FOV: 45 degrees. Fundus photo:
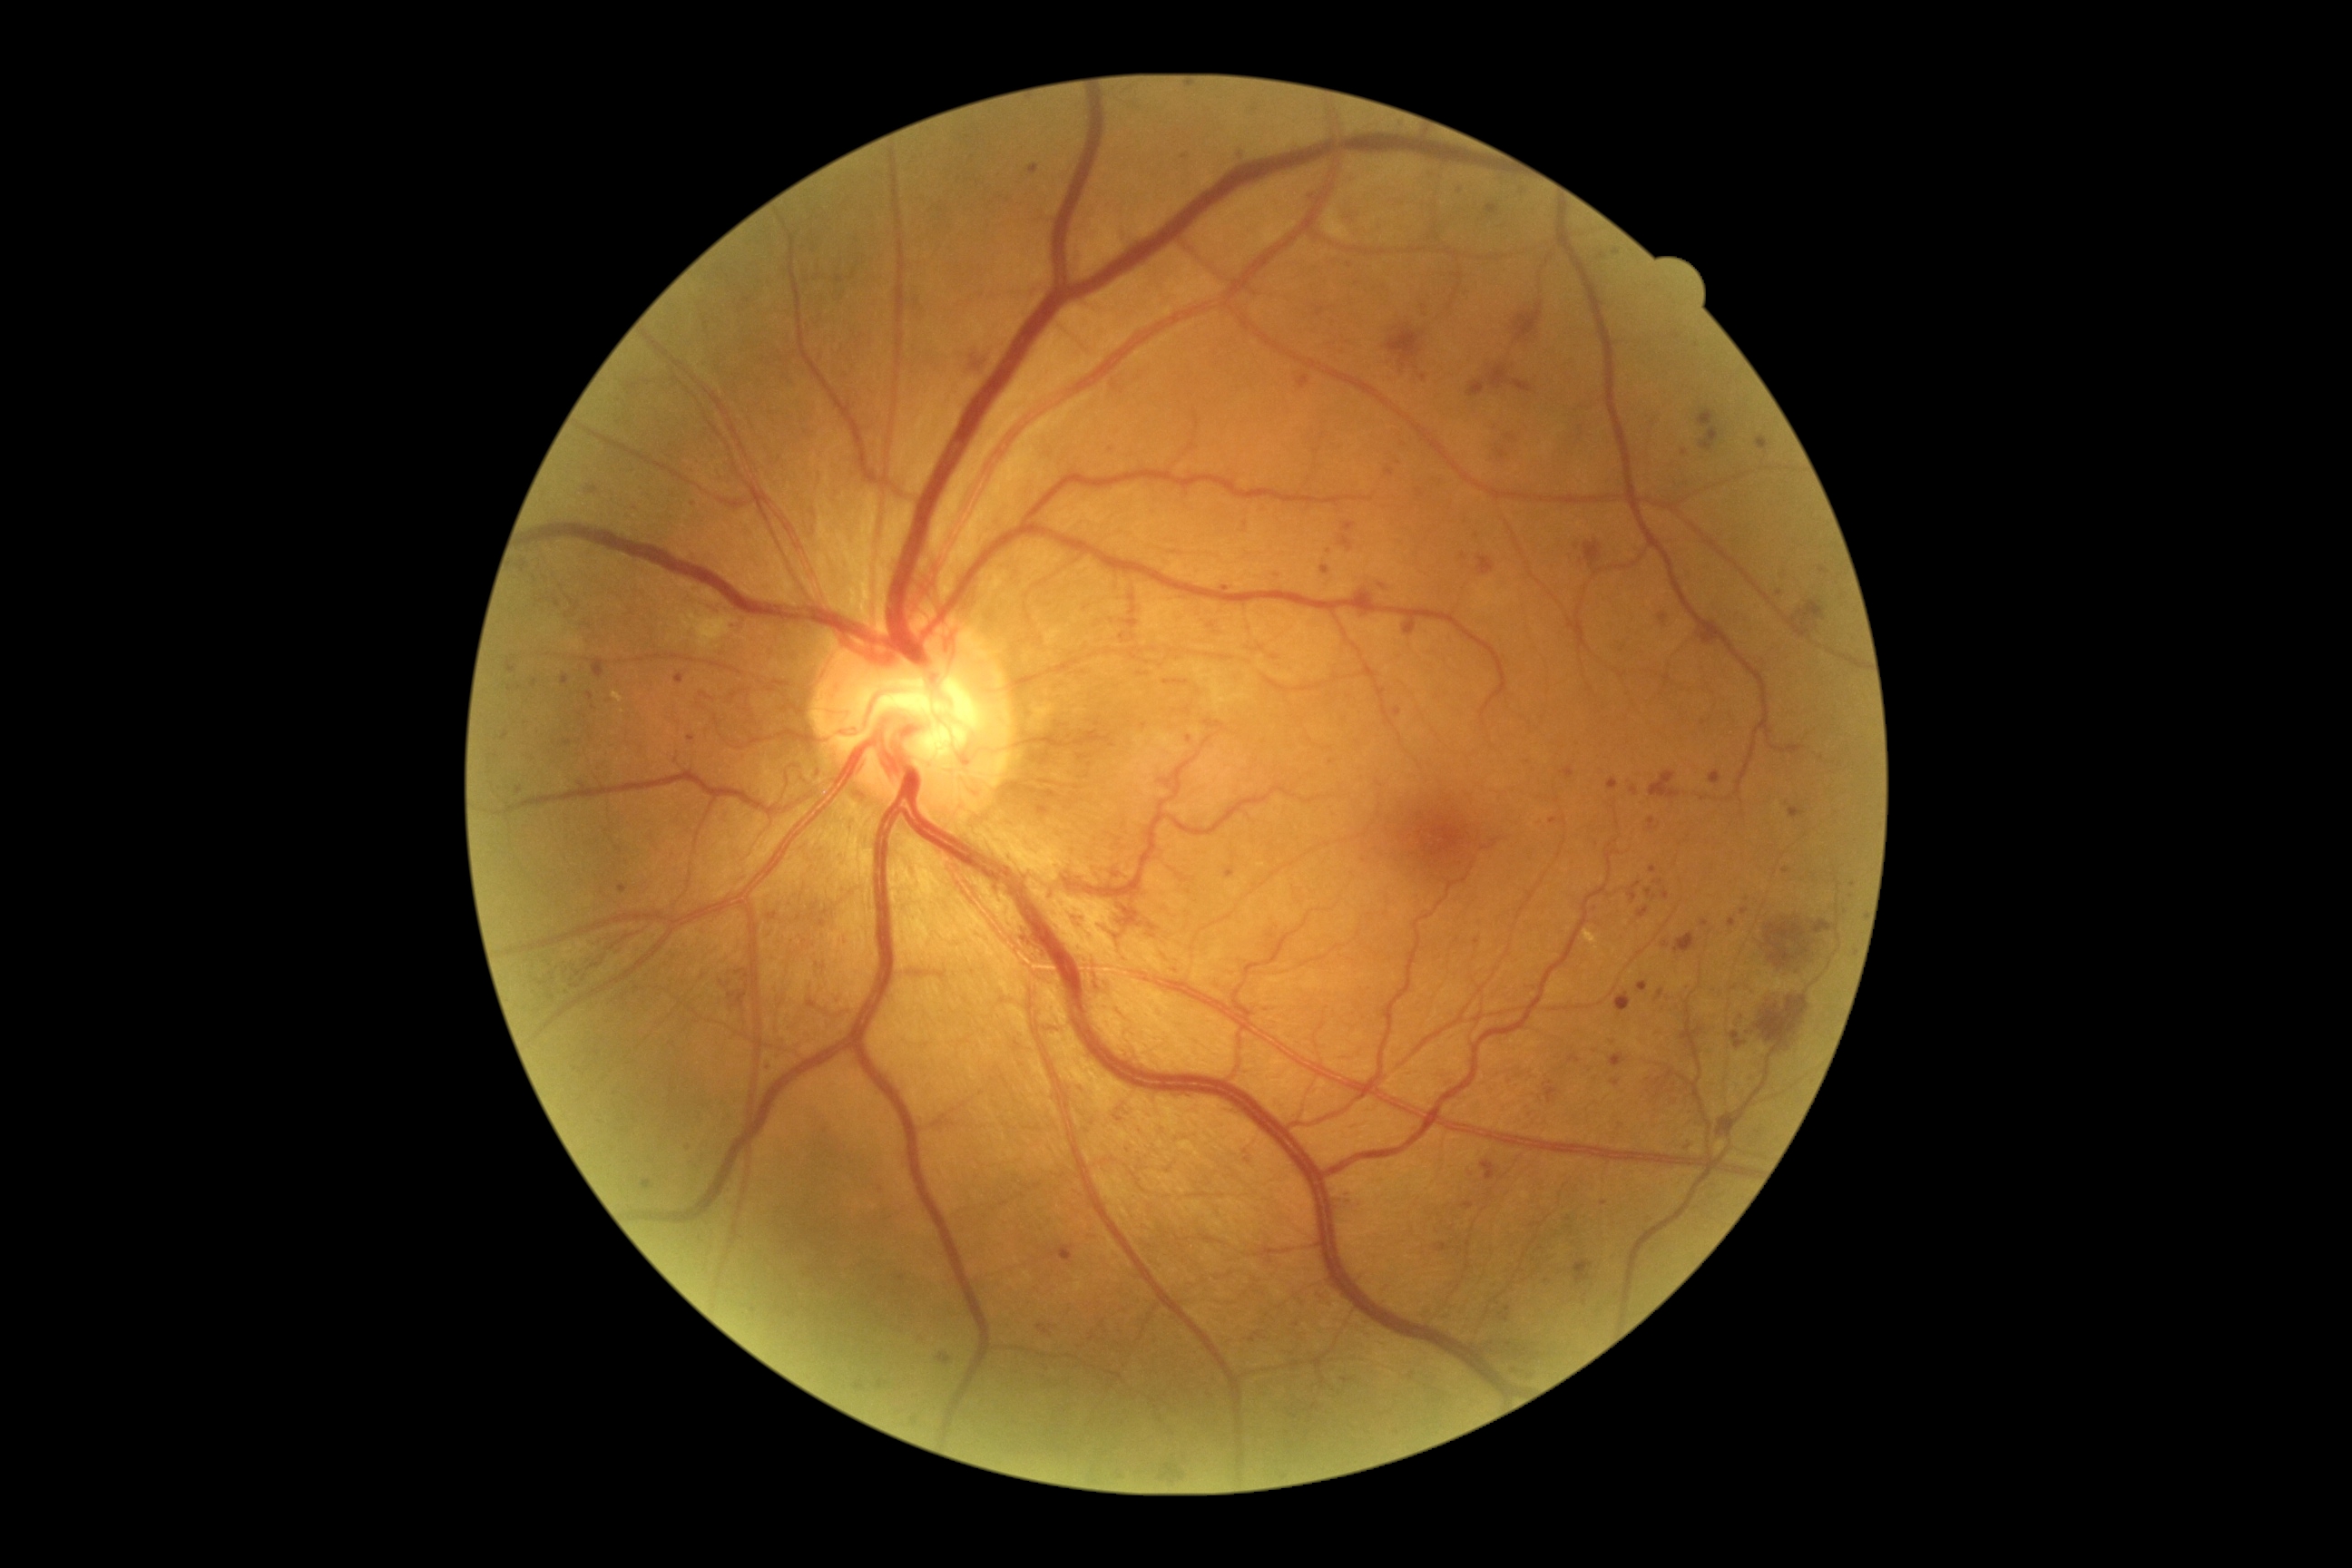 DR grade = proliferative diabetic retinopathy (4) | DR class = proliferative diabetic retinopathy.